UWF retinal mosaic — 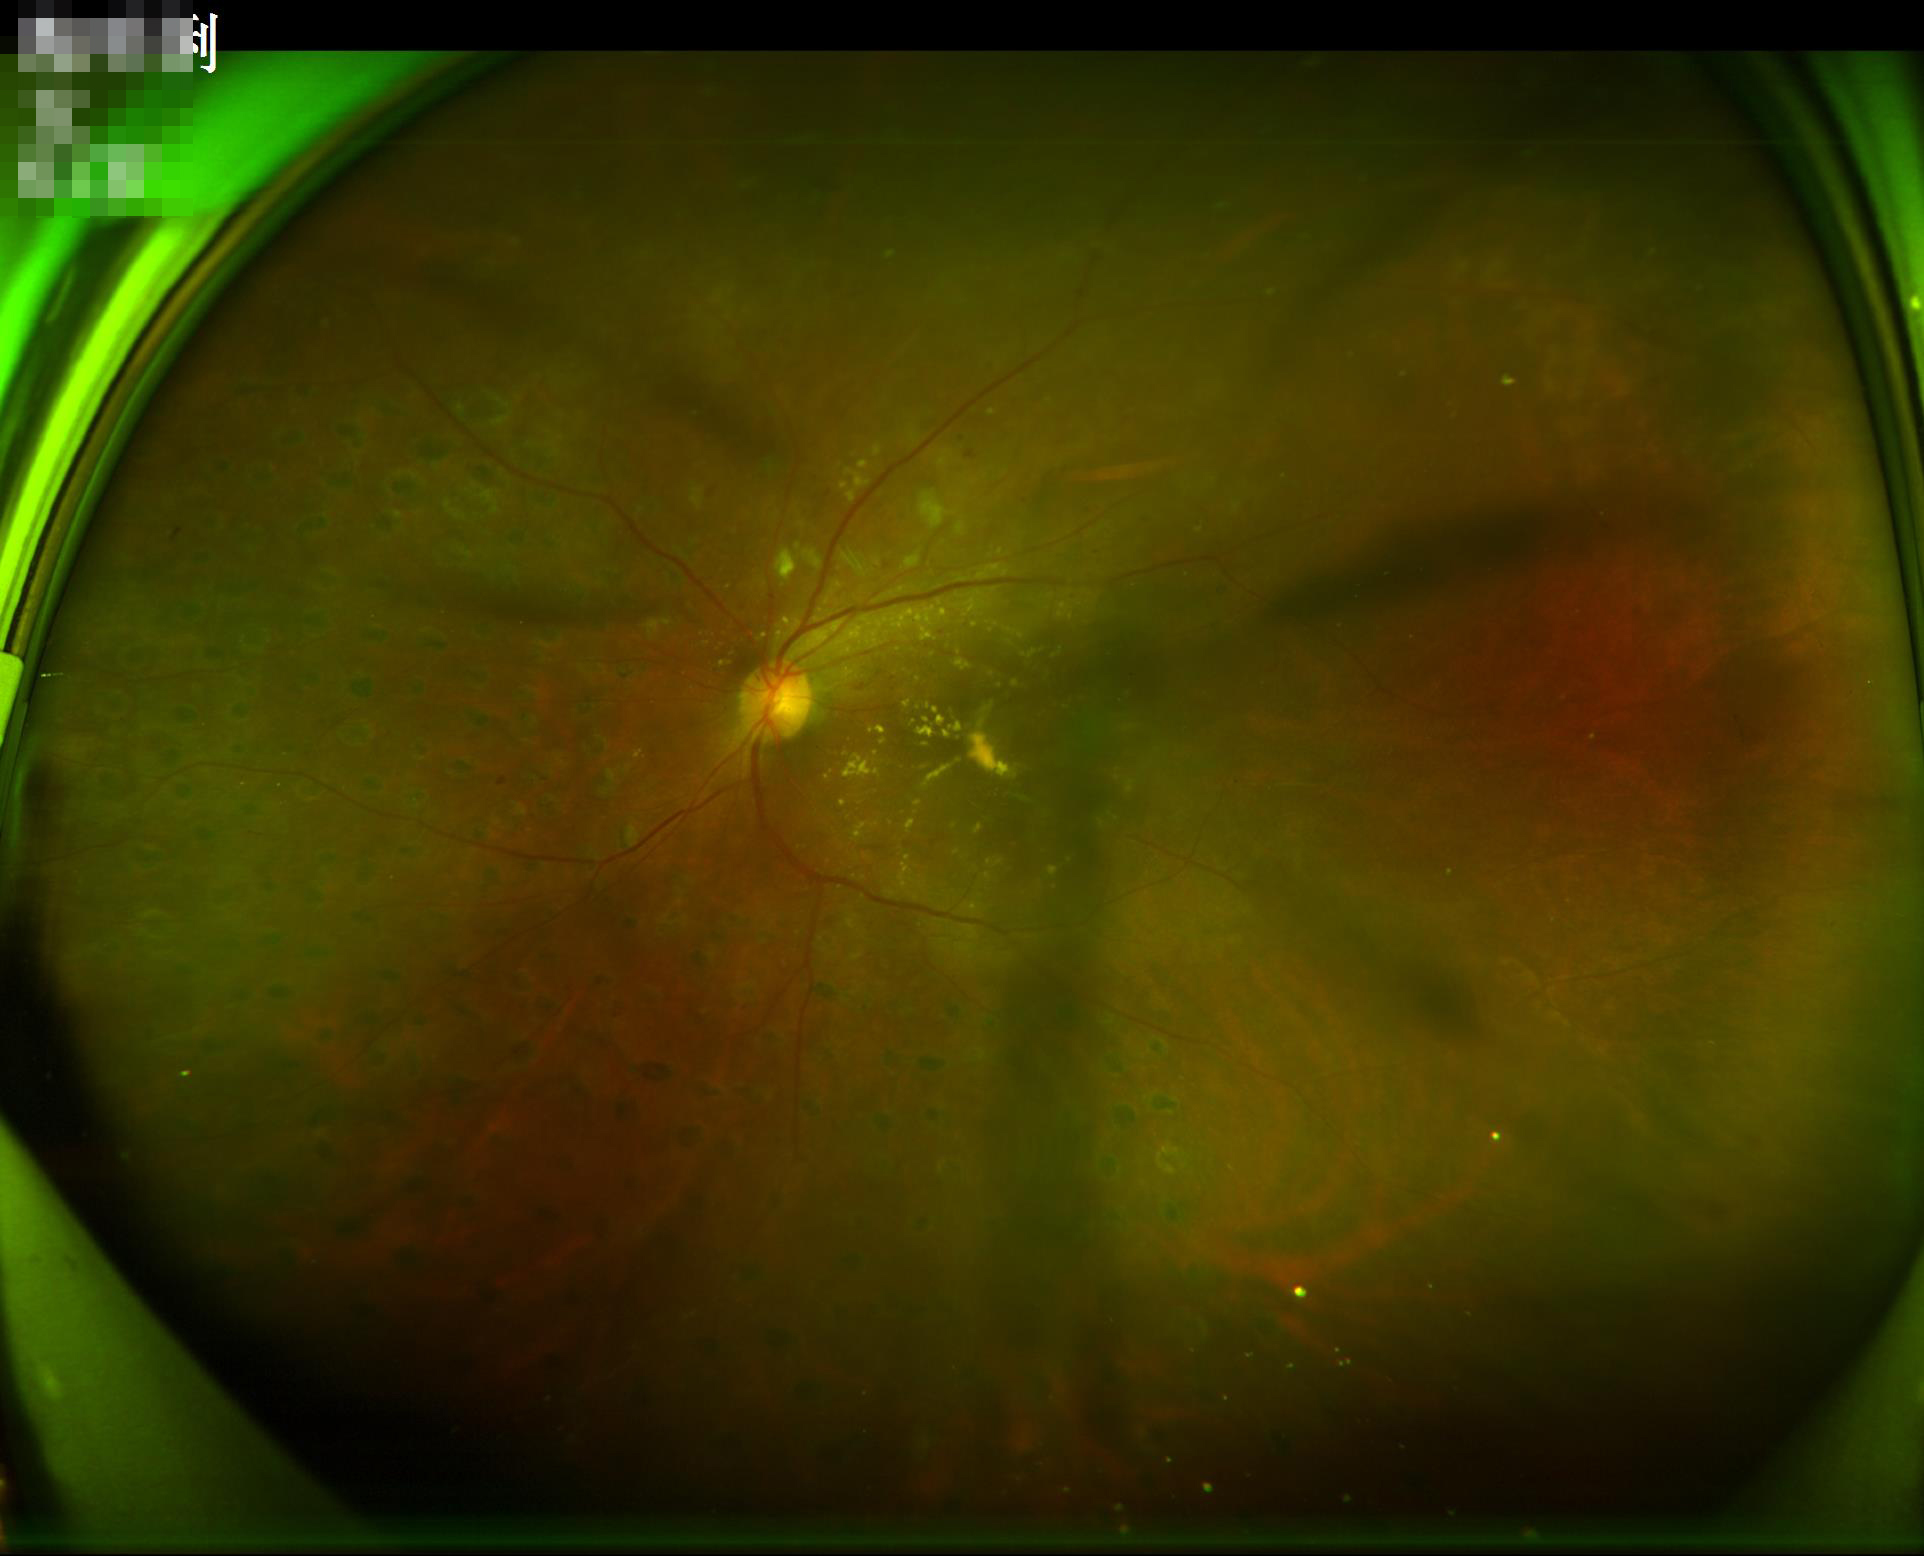 Image quality assessment: overall: inadequate for clinical interpretation; focus: optic disc, vessels, and background in focus; illumination/color: over- or under-exposed; contrast: vessels and details readily distinguishable.